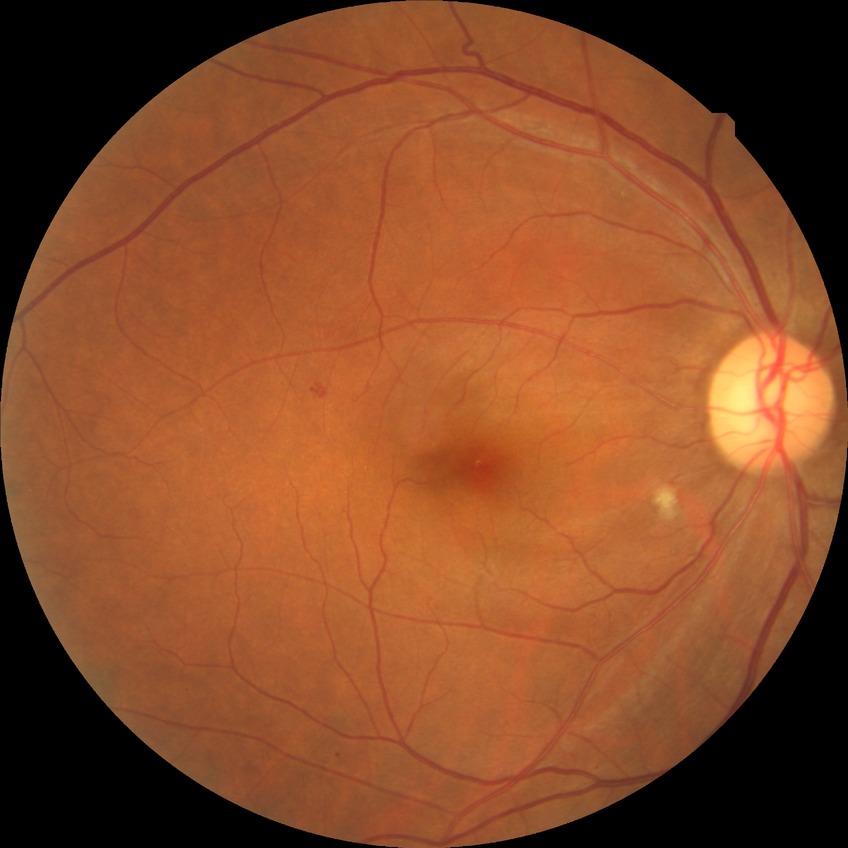

* diabetic retinopathy (DR): pre-proliferative diabetic retinopathy (PPDR)